Color fundus photograph from a handheld portable camera.
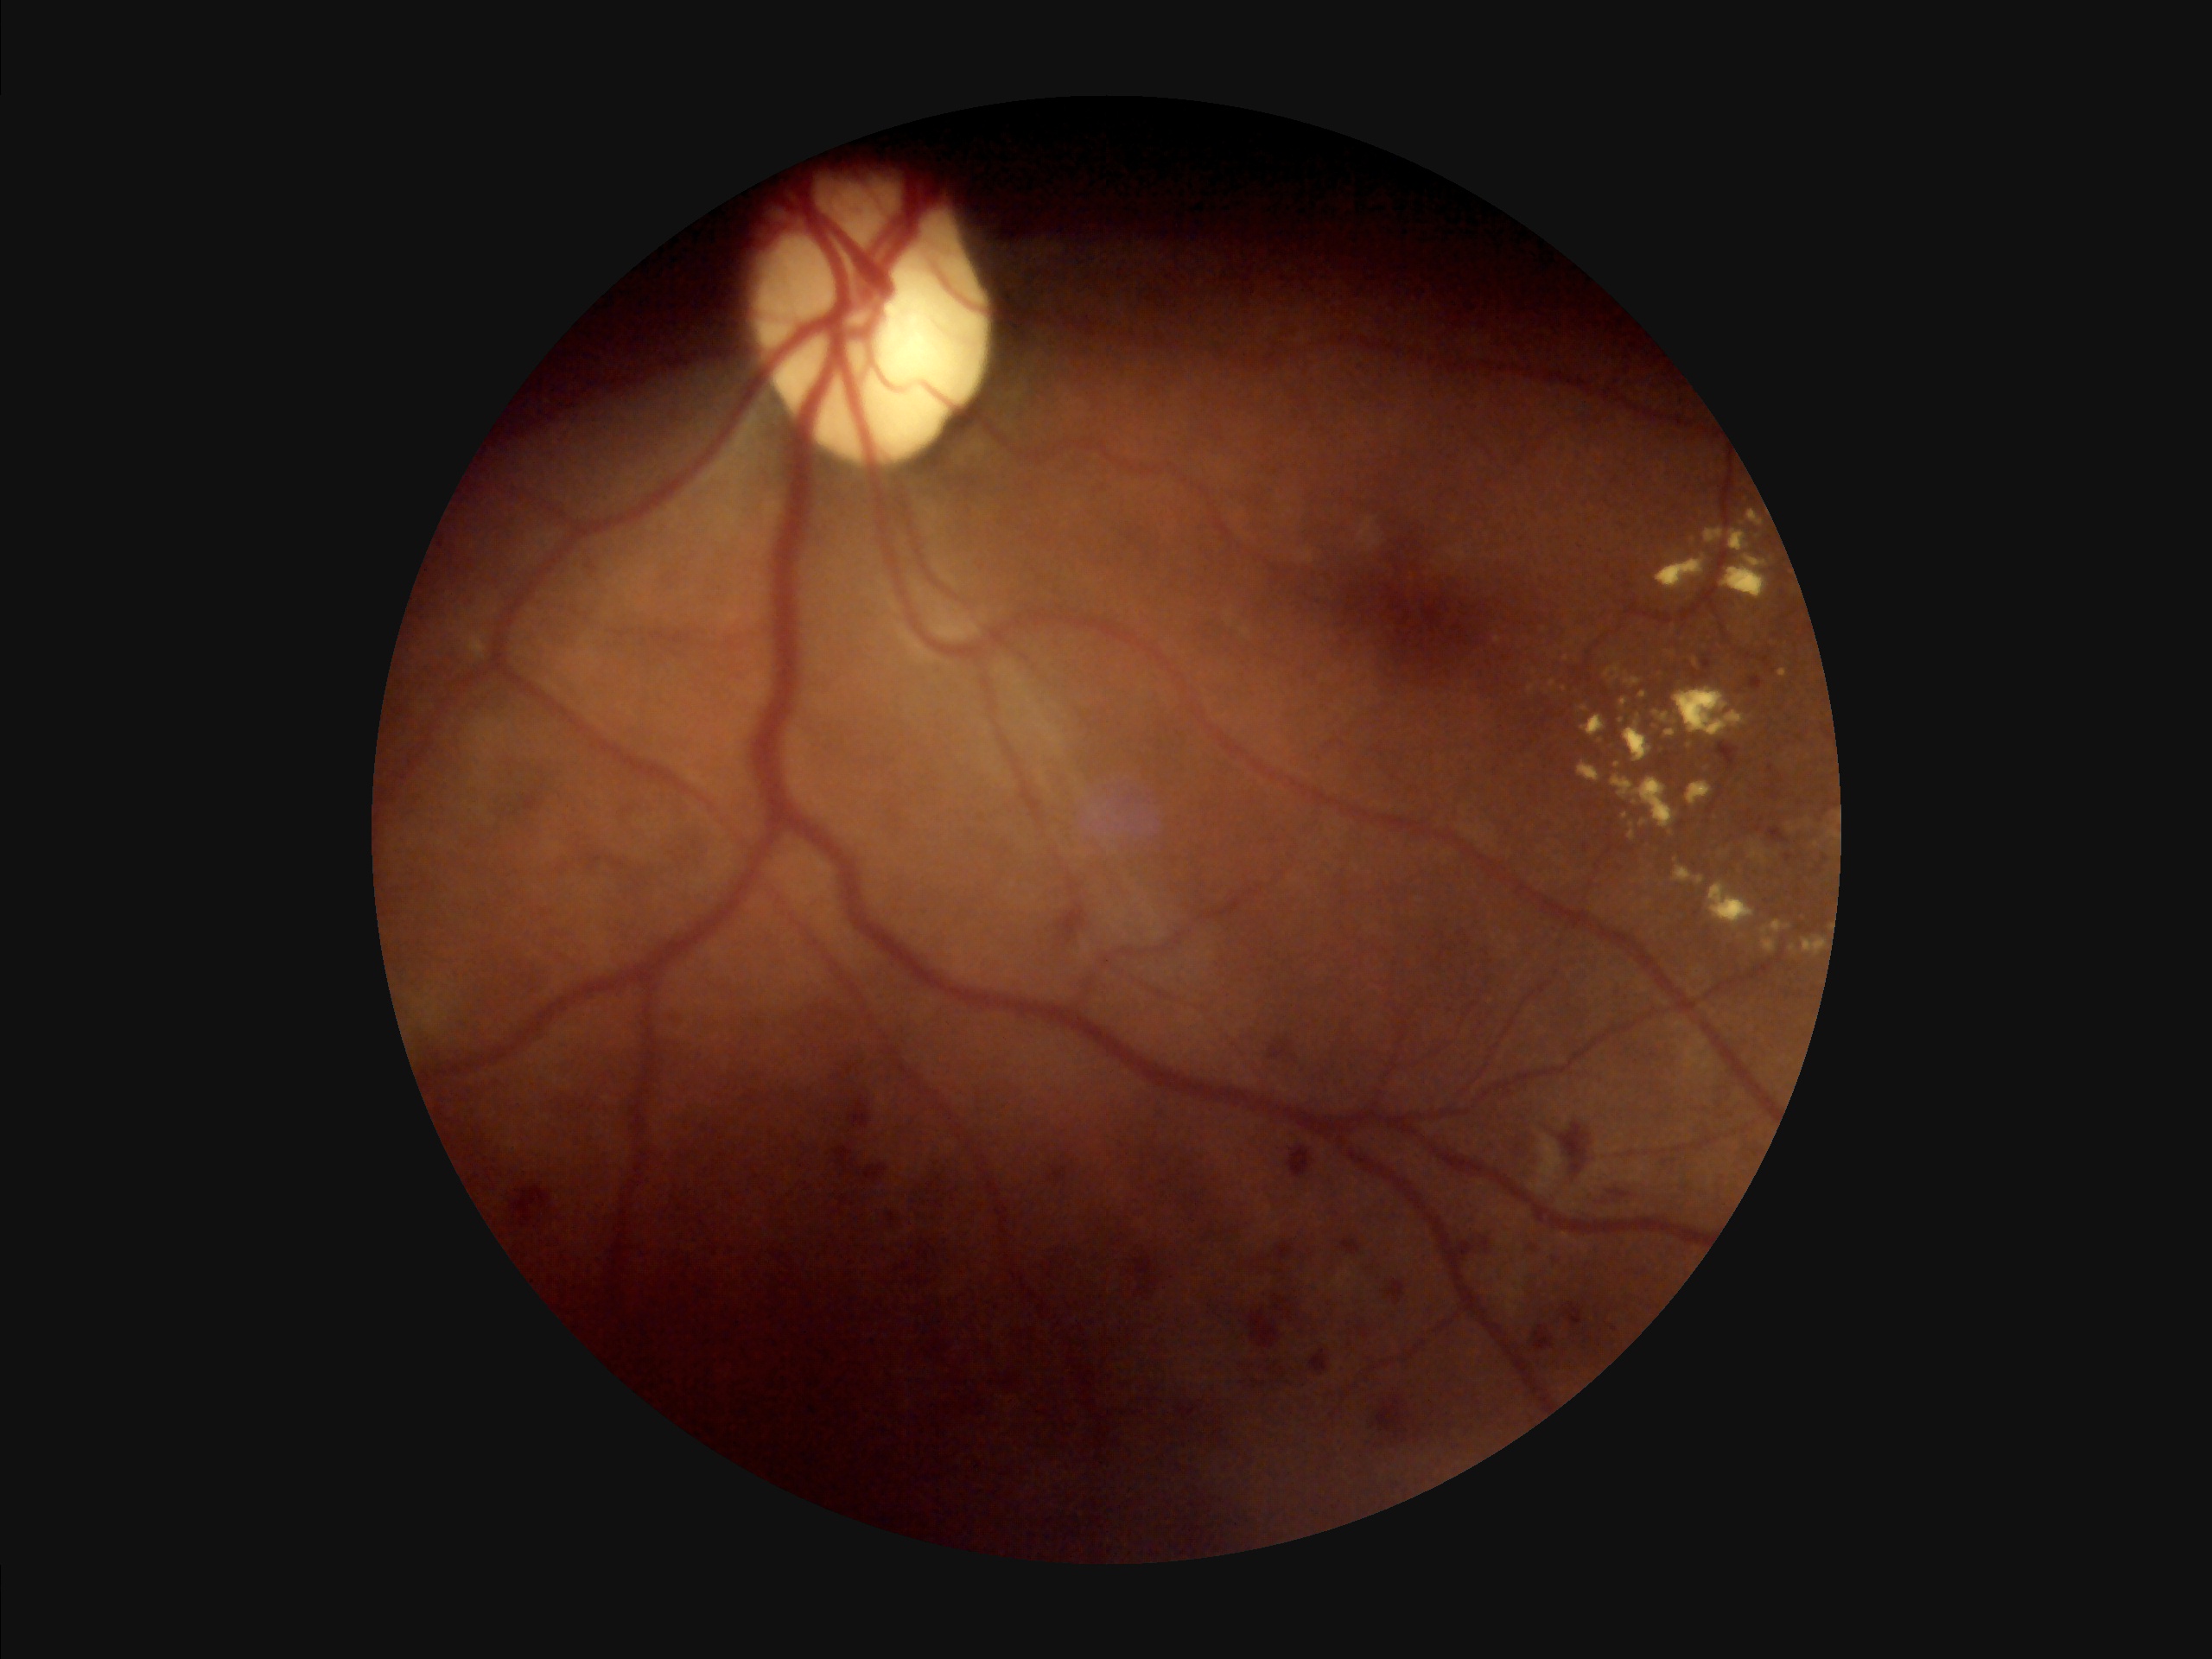 Good dynamic range.
Overall quality is poor; the image is difficult to grade.
No noticeable blur.
There is over- or under-exposure or a color cast.